640x480px; Clarity RetCam 3, 130° FOV; RetCam wide-field infant fundus image.
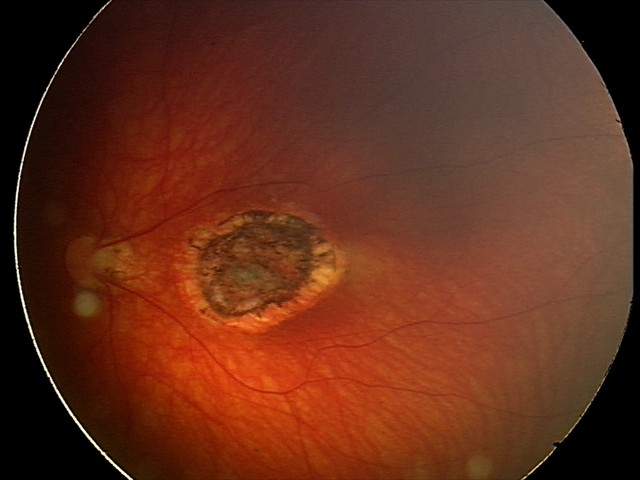
Assessment = toxoplasmosis chorioretinitis.